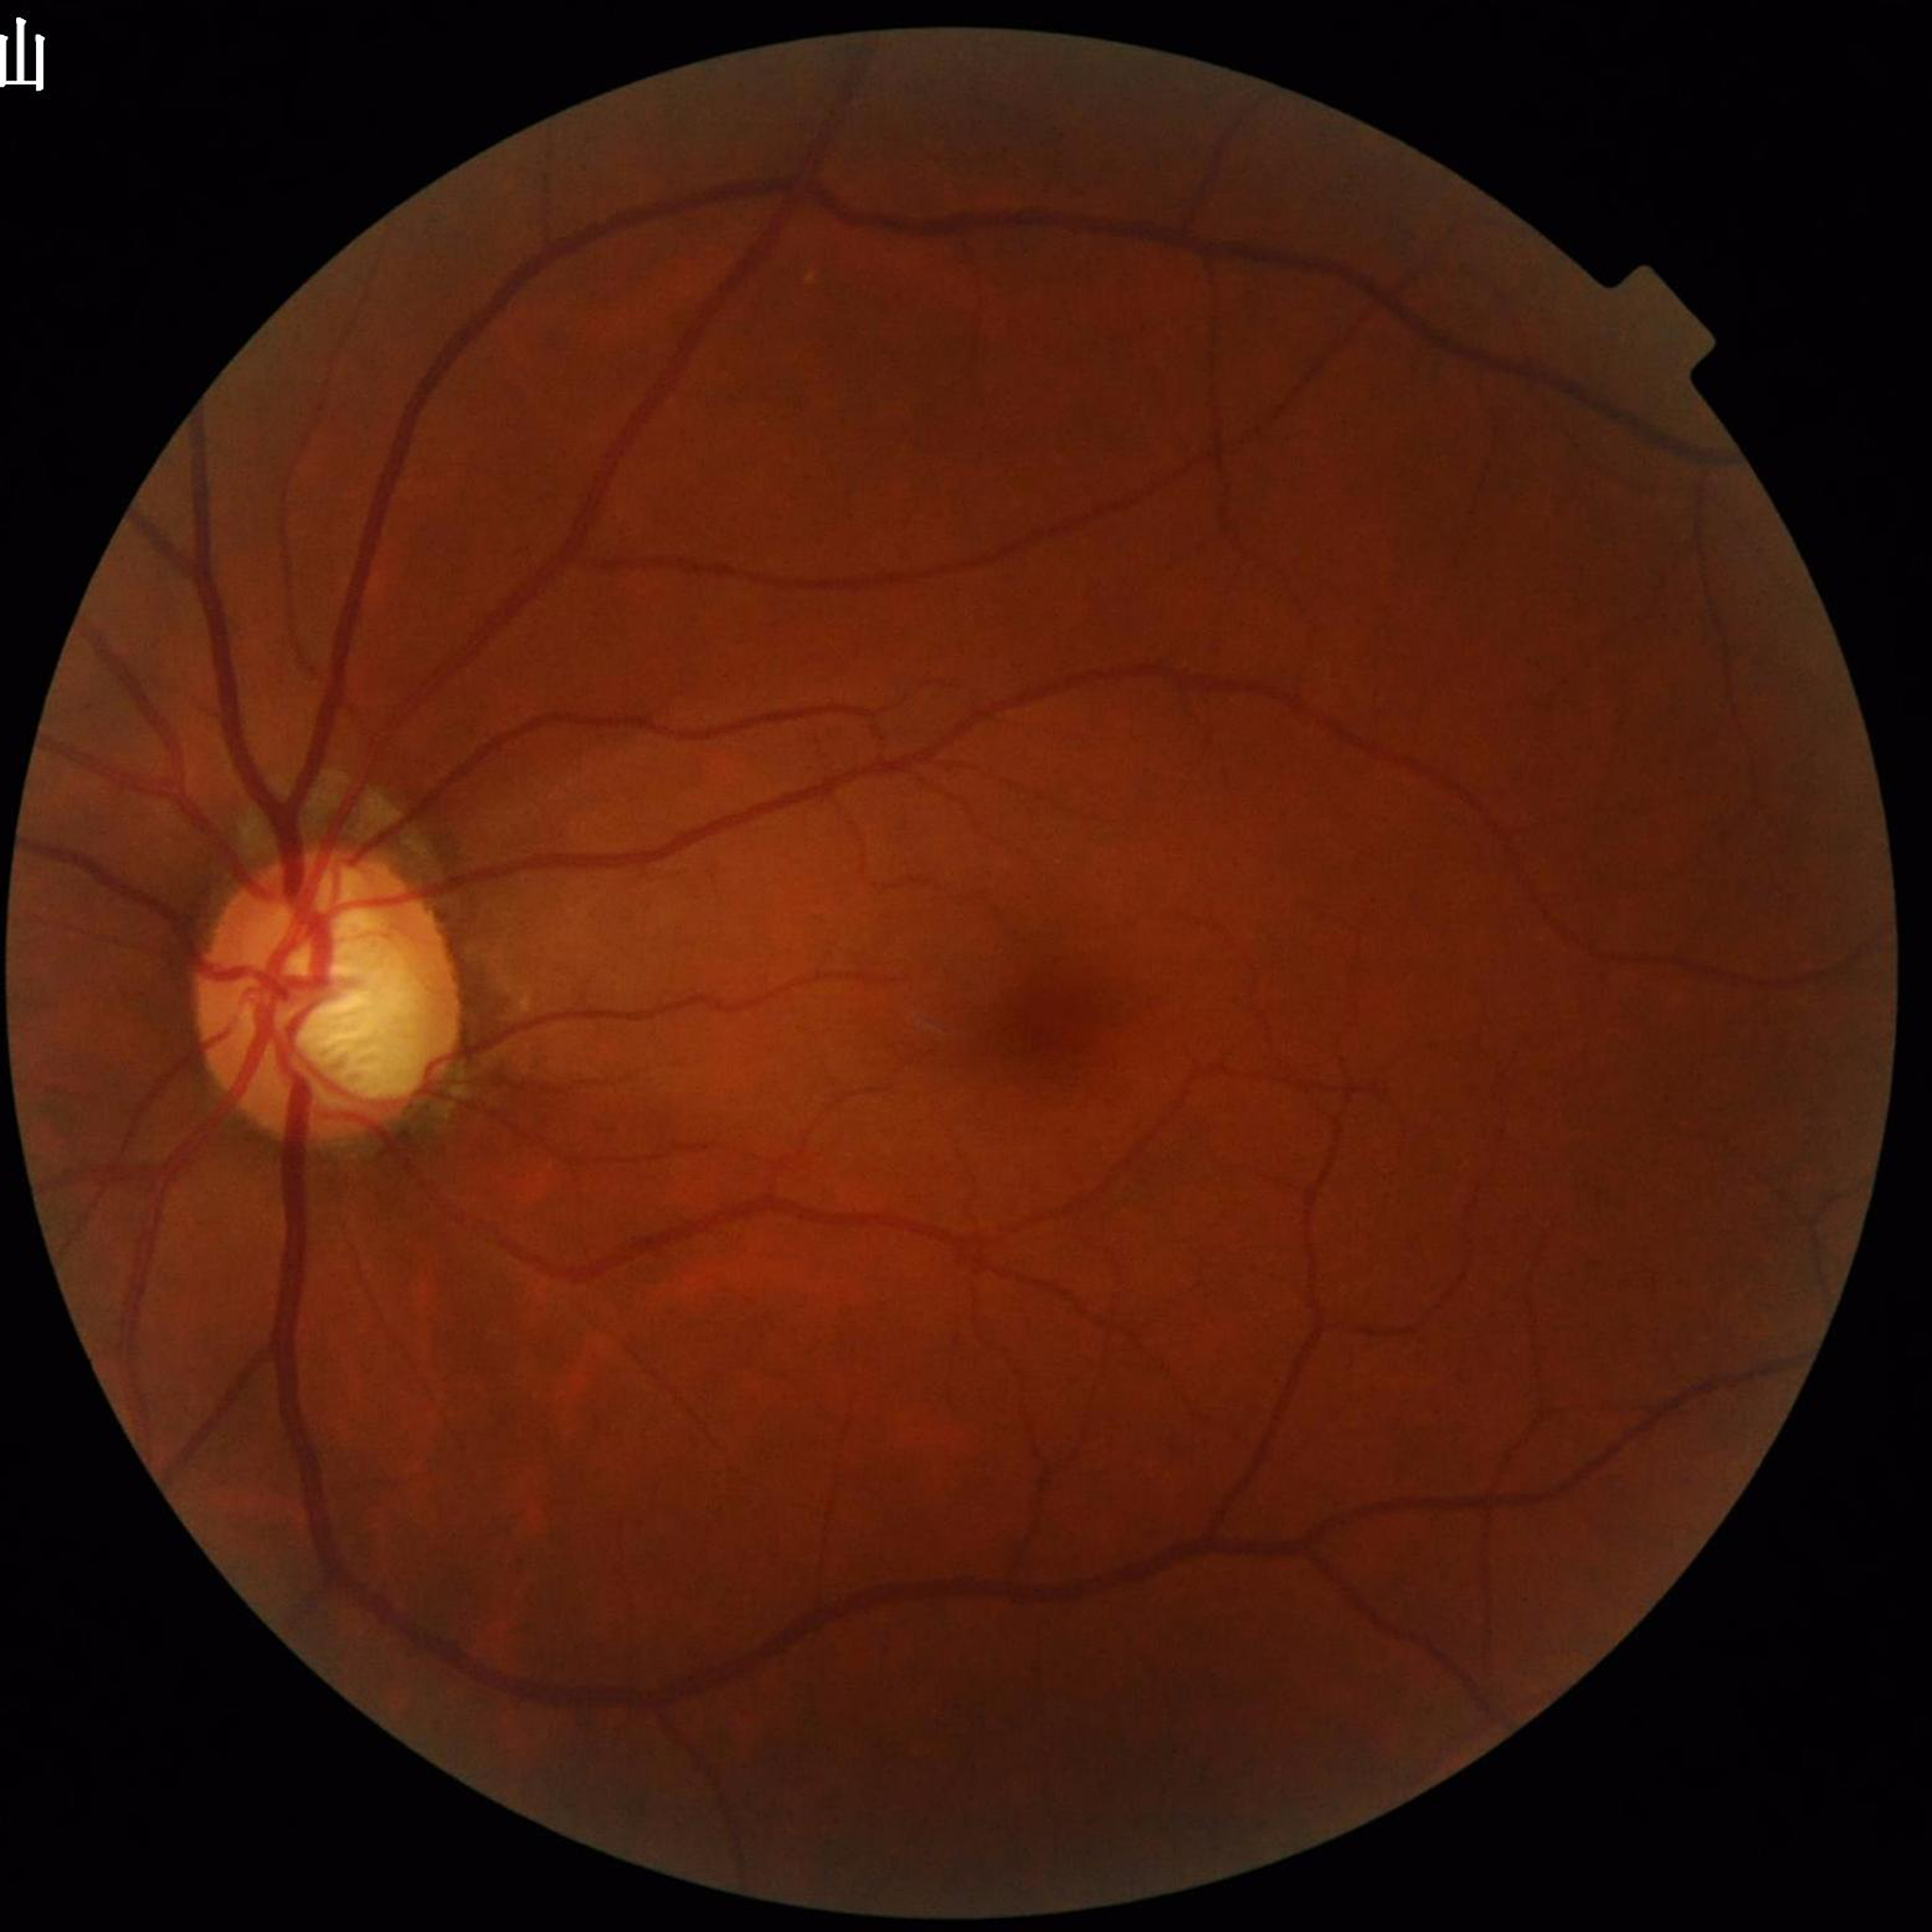

Automated quality assessment: satisfactory; Disease: glaucoma.